45° FOV: 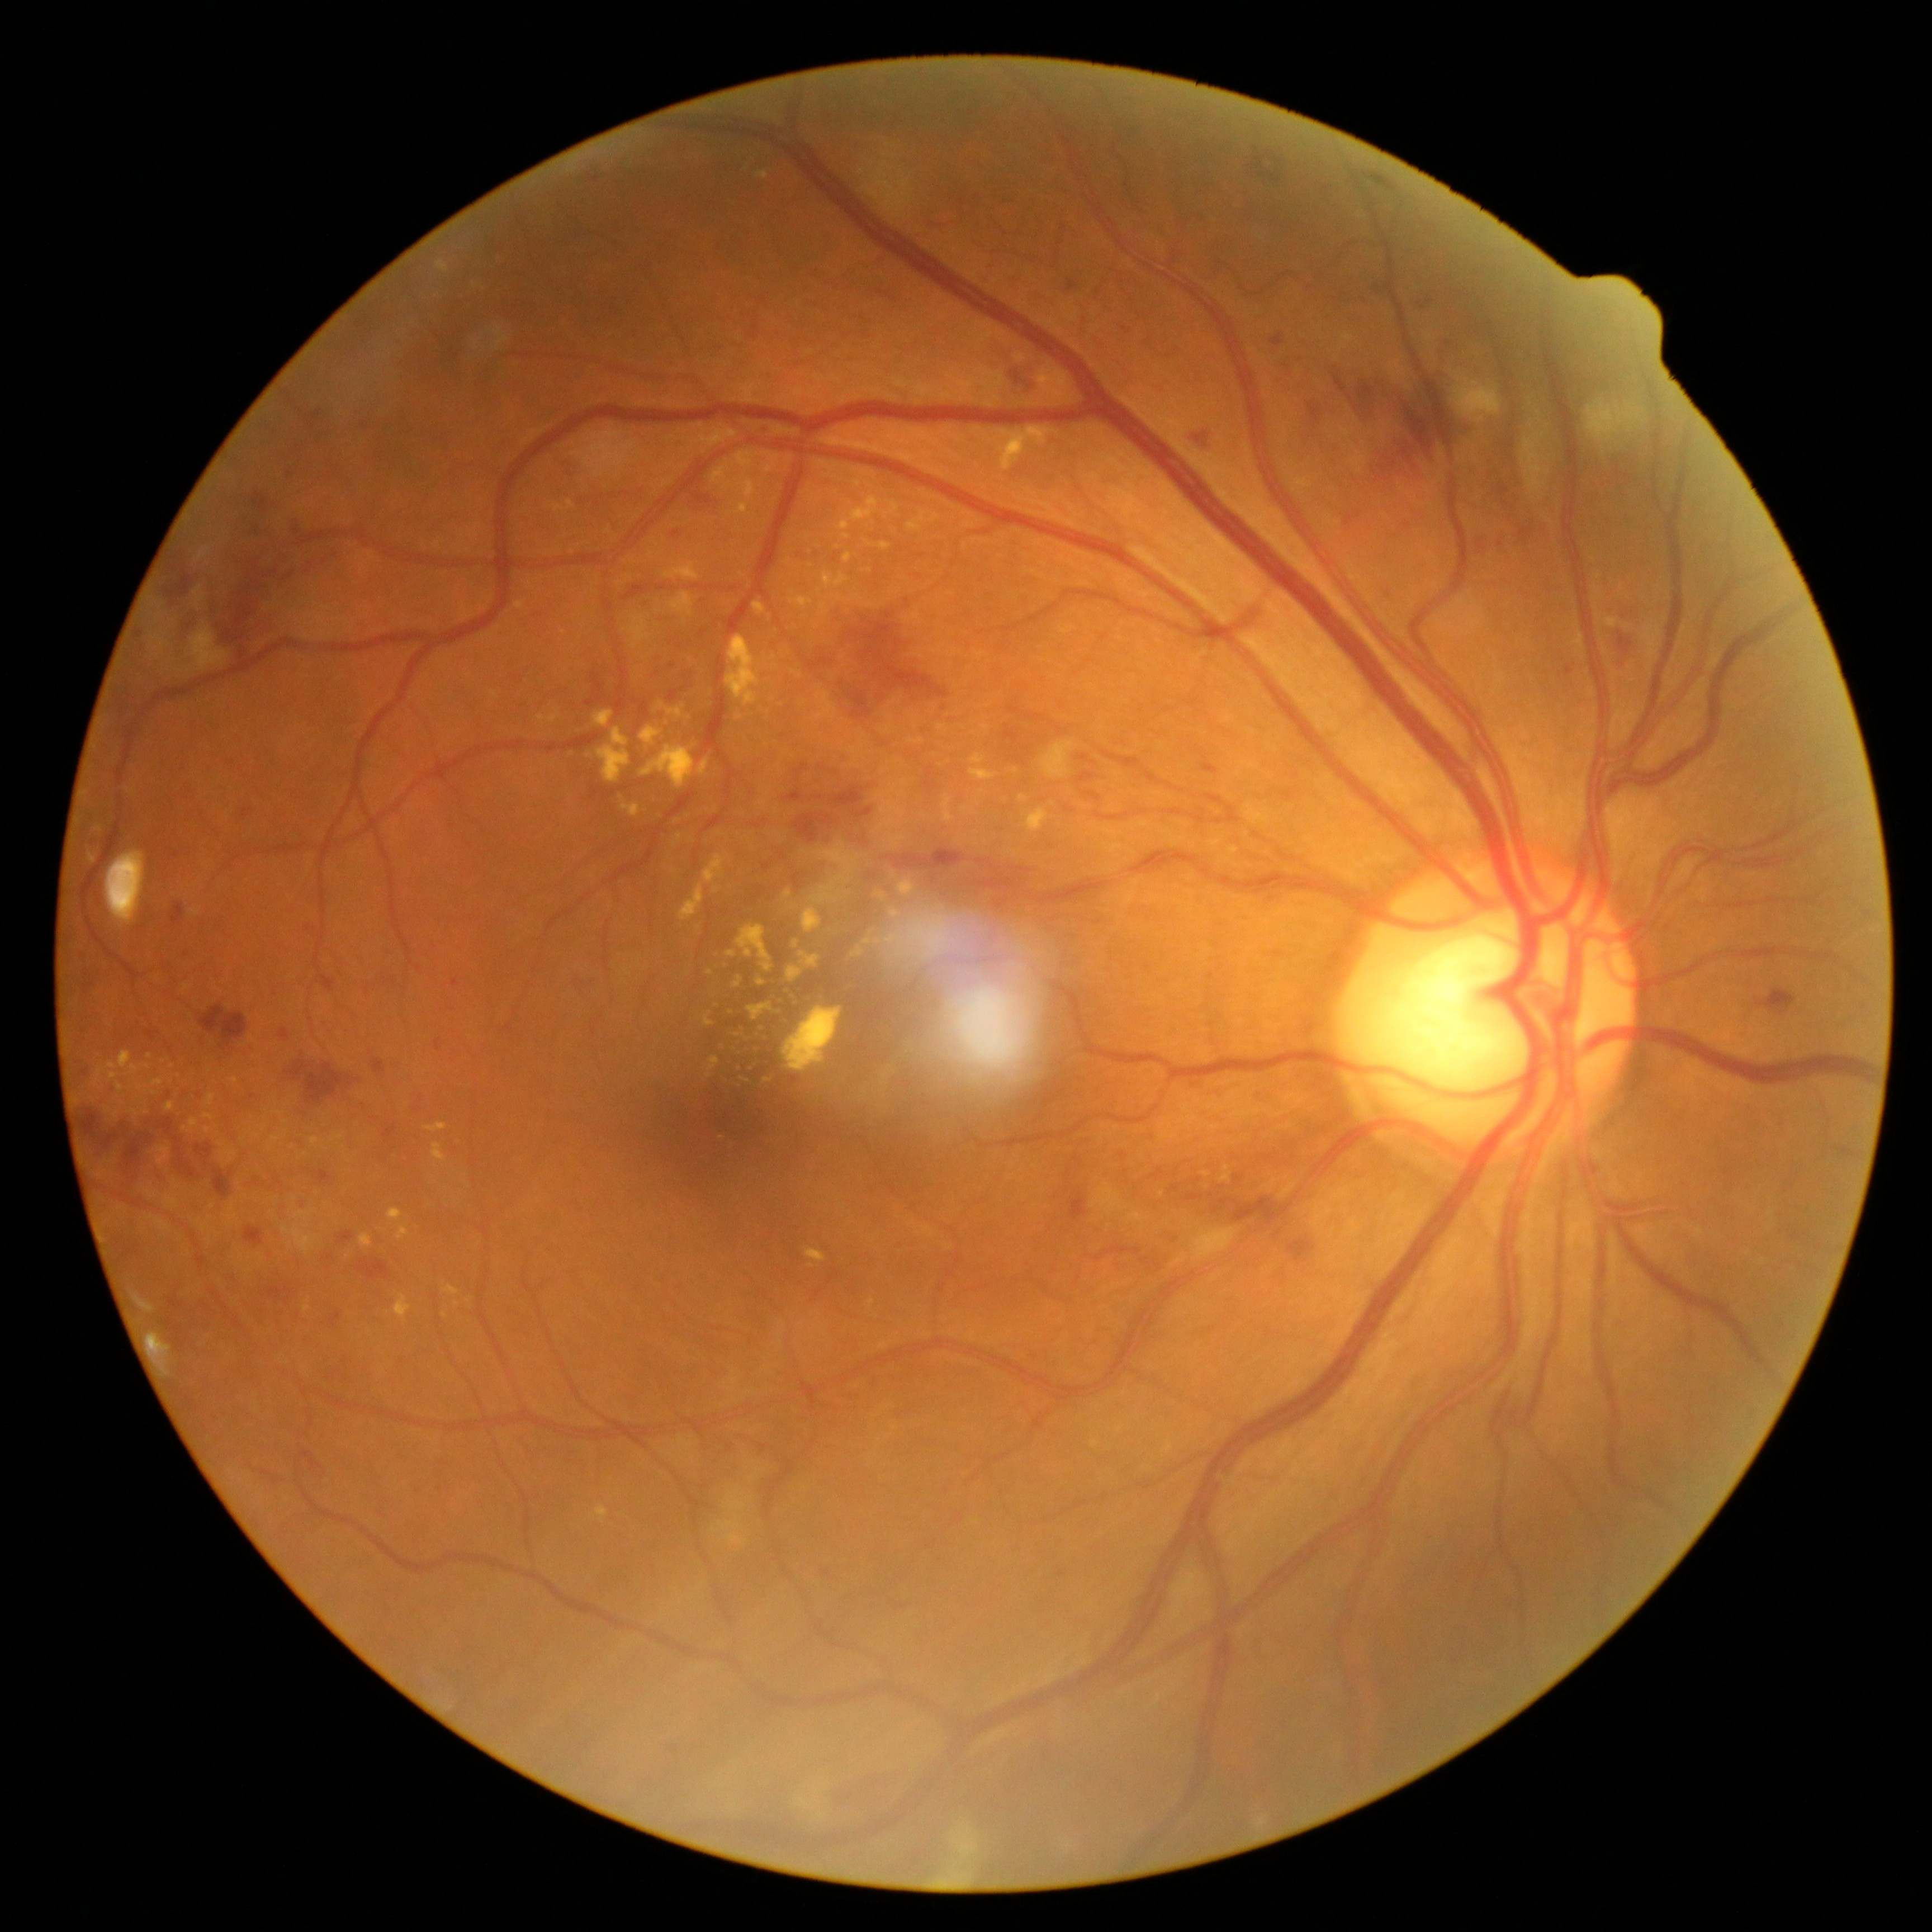 <lesions partial="true">
  <dr_grade>3</dr_grade>
  <ex partial="true">x1=970 y1=768 x2=998 y2=782 | x1=790 y1=669 x2=802 y2=678 | x1=205 y1=1095 x2=216 y2=1109 | x1=853 y1=948 x2=865 y2=959 | x1=1024 y1=809 x2=1050 y2=832 | x1=997 y1=424 x2=1044 y2=466 | x1=484 y1=255 x2=498 y2=261 | x1=554 y1=506 x2=565 y2=513 | x1=427 y1=1124 x2=448 y2=1133 | x1=622 y1=804 x2=640 y2=819</ex>
  <ex_small_centers>(716, 1005) | (892, 911) | (819, 592) | (985, 728) | (775, 658) | (755, 1051) | (741, 1088) | (716, 890)</ex_small_centers>
</lesions>